Modified Davis grading: 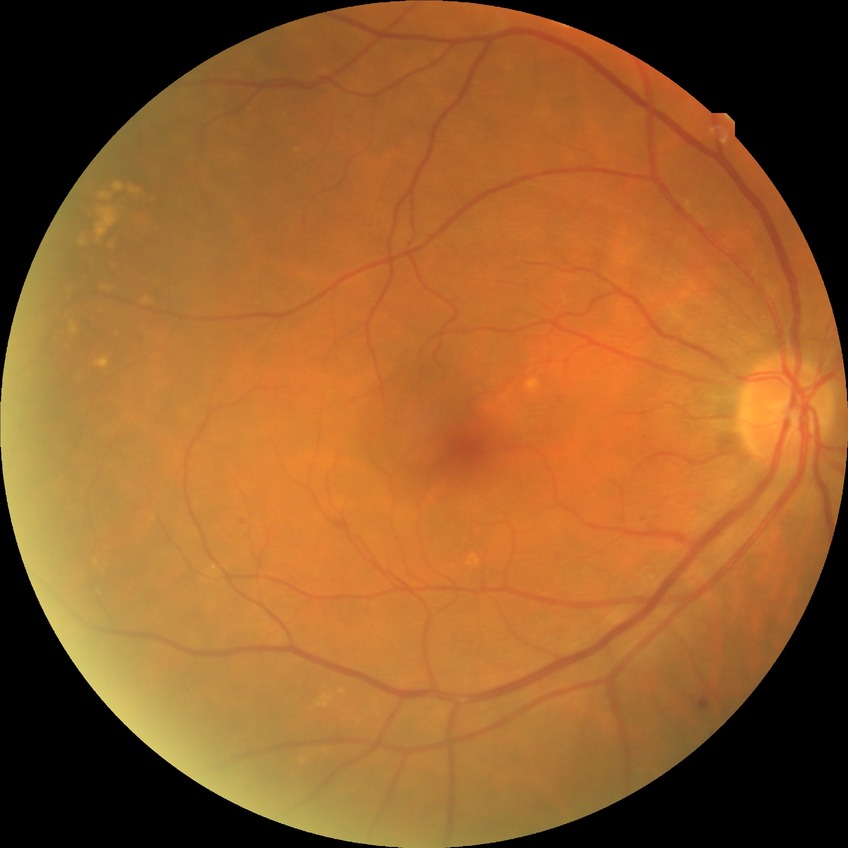

Davis grading is simple diabetic retinopathy.